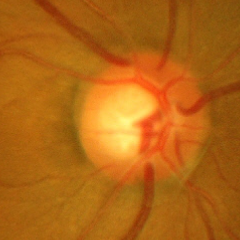 Glaucomatous optic neuropathy is present. Fundus image with findings of severe glaucomatous damage.